Fundus photo: 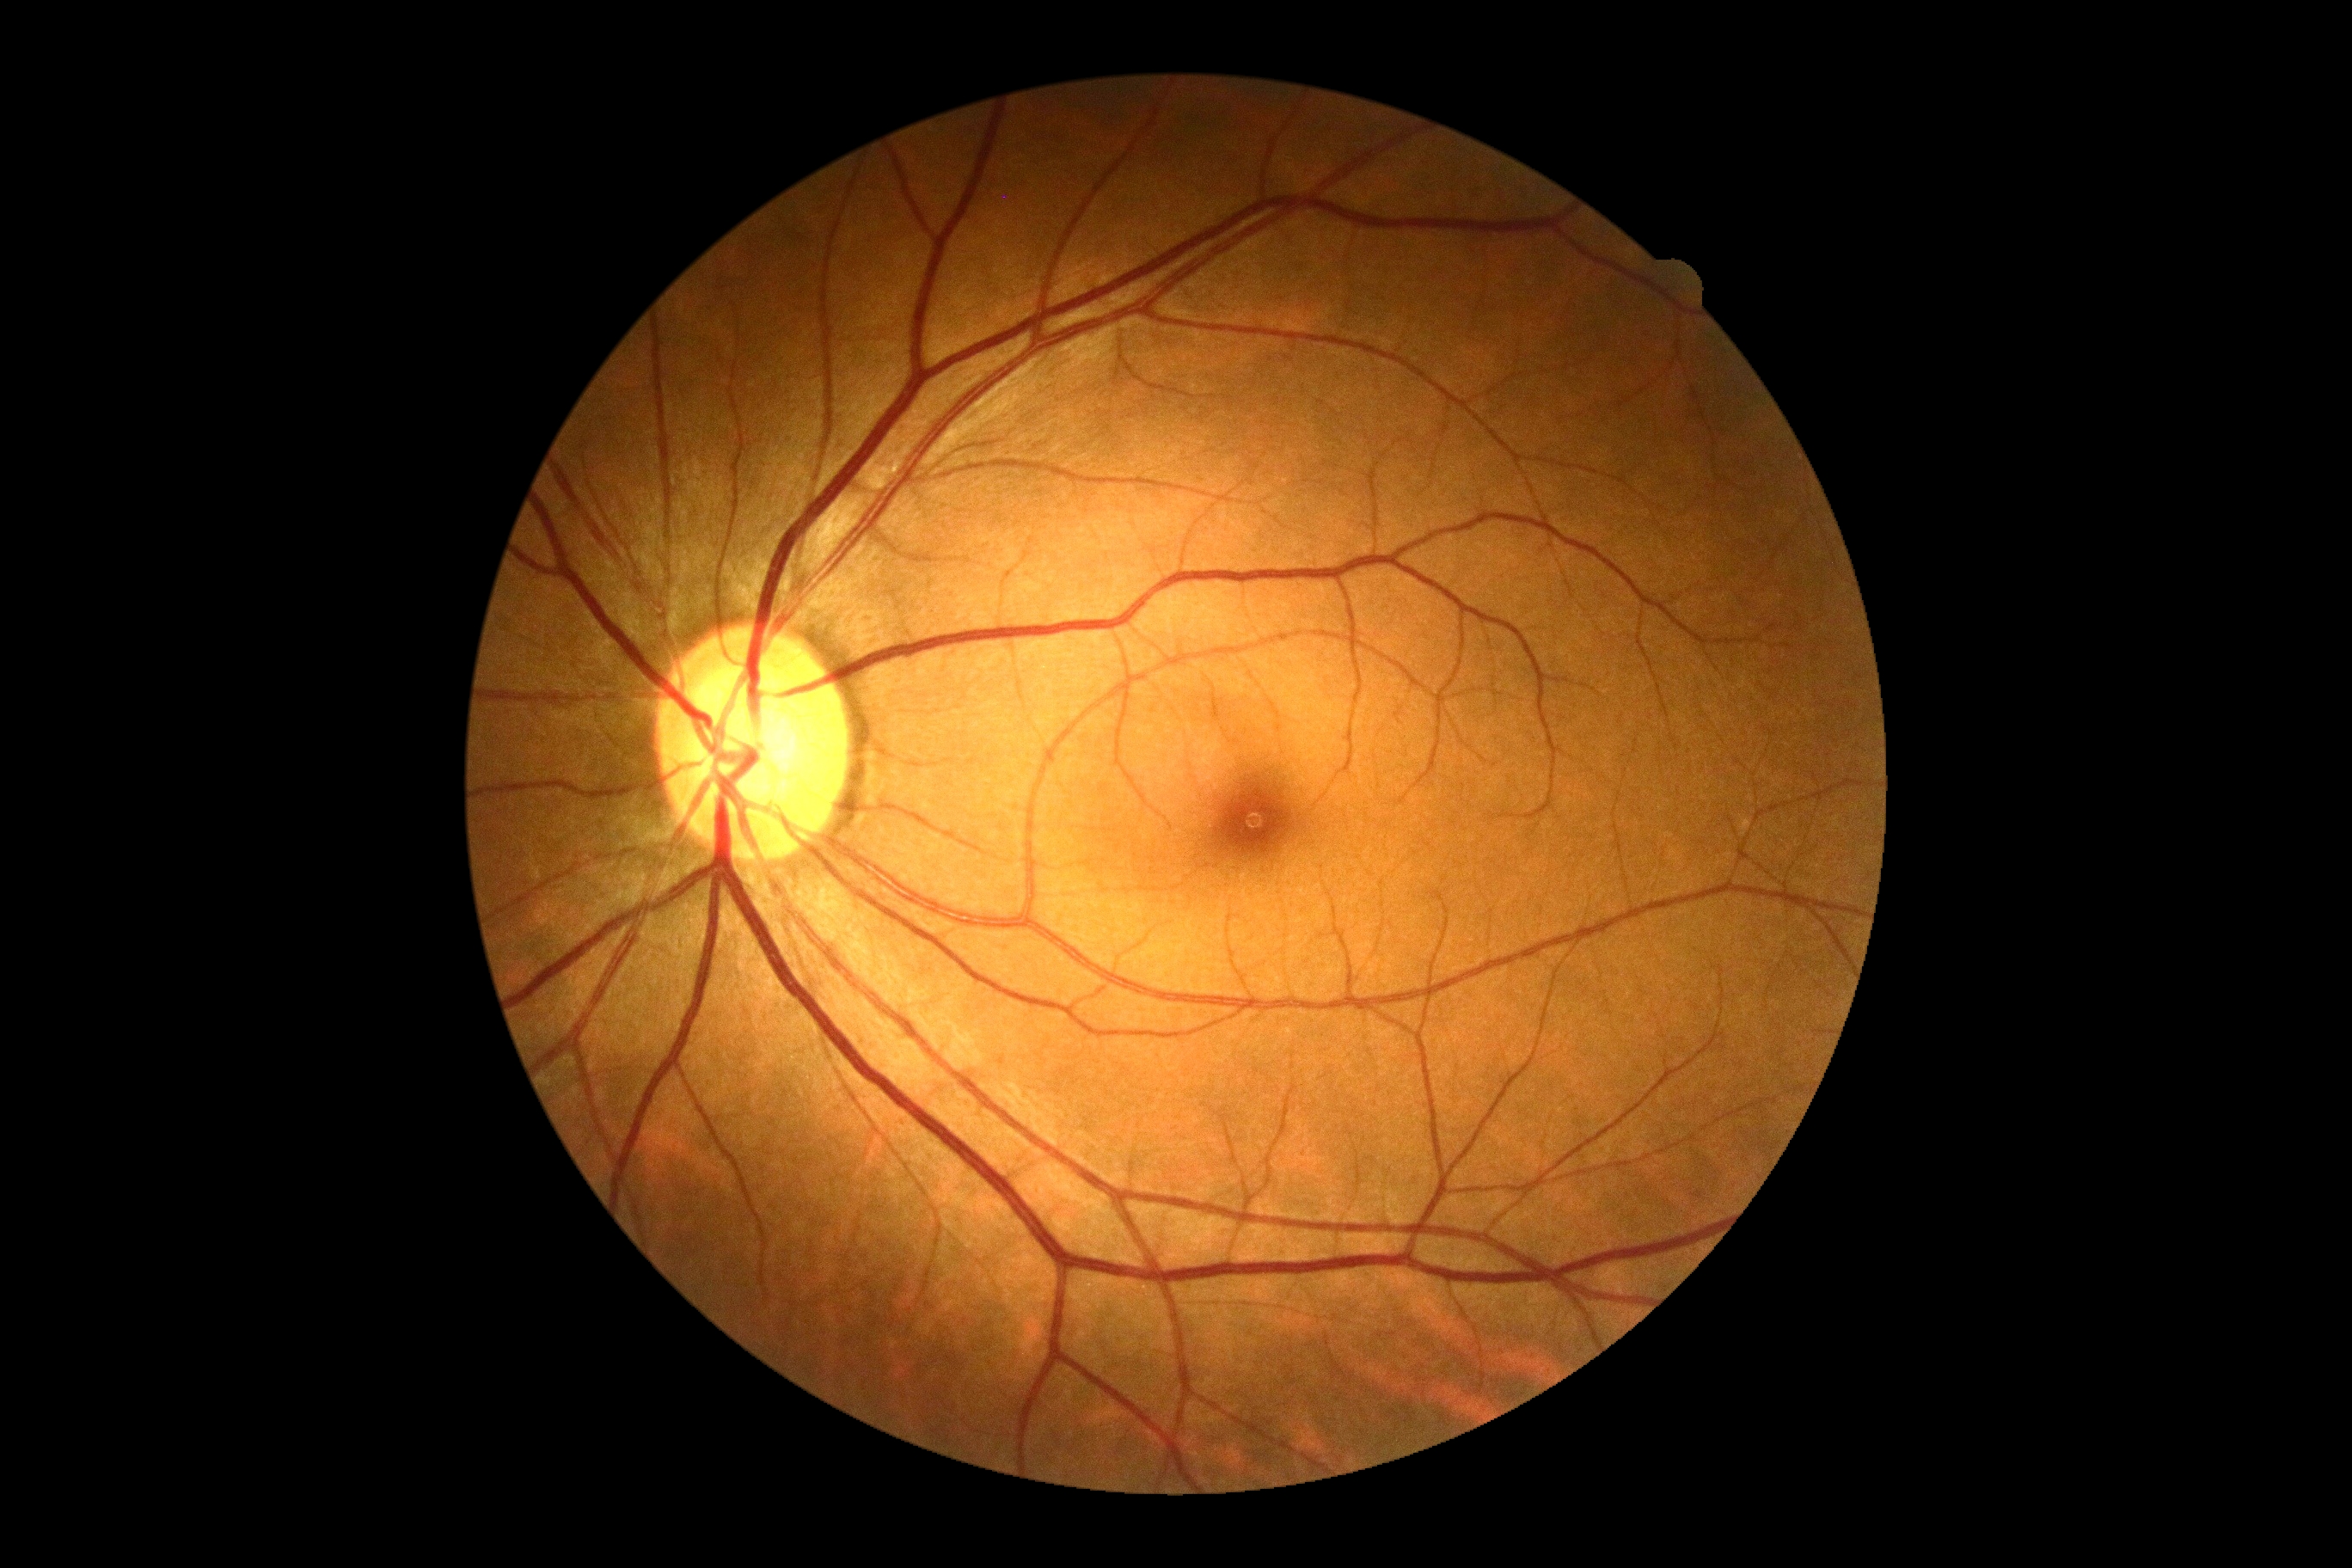 DR grade is no apparent retinopathy (0).
No DR findings.